45° FOV · without pupil dilation · 848 by 848 pixels:
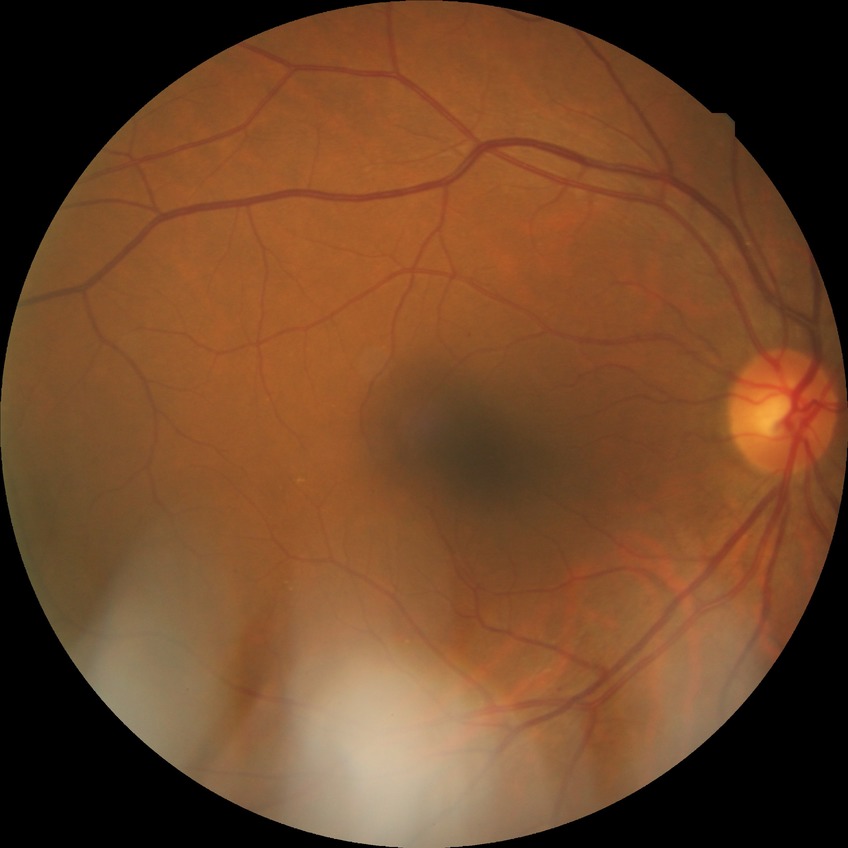
- Davis stage — SDR